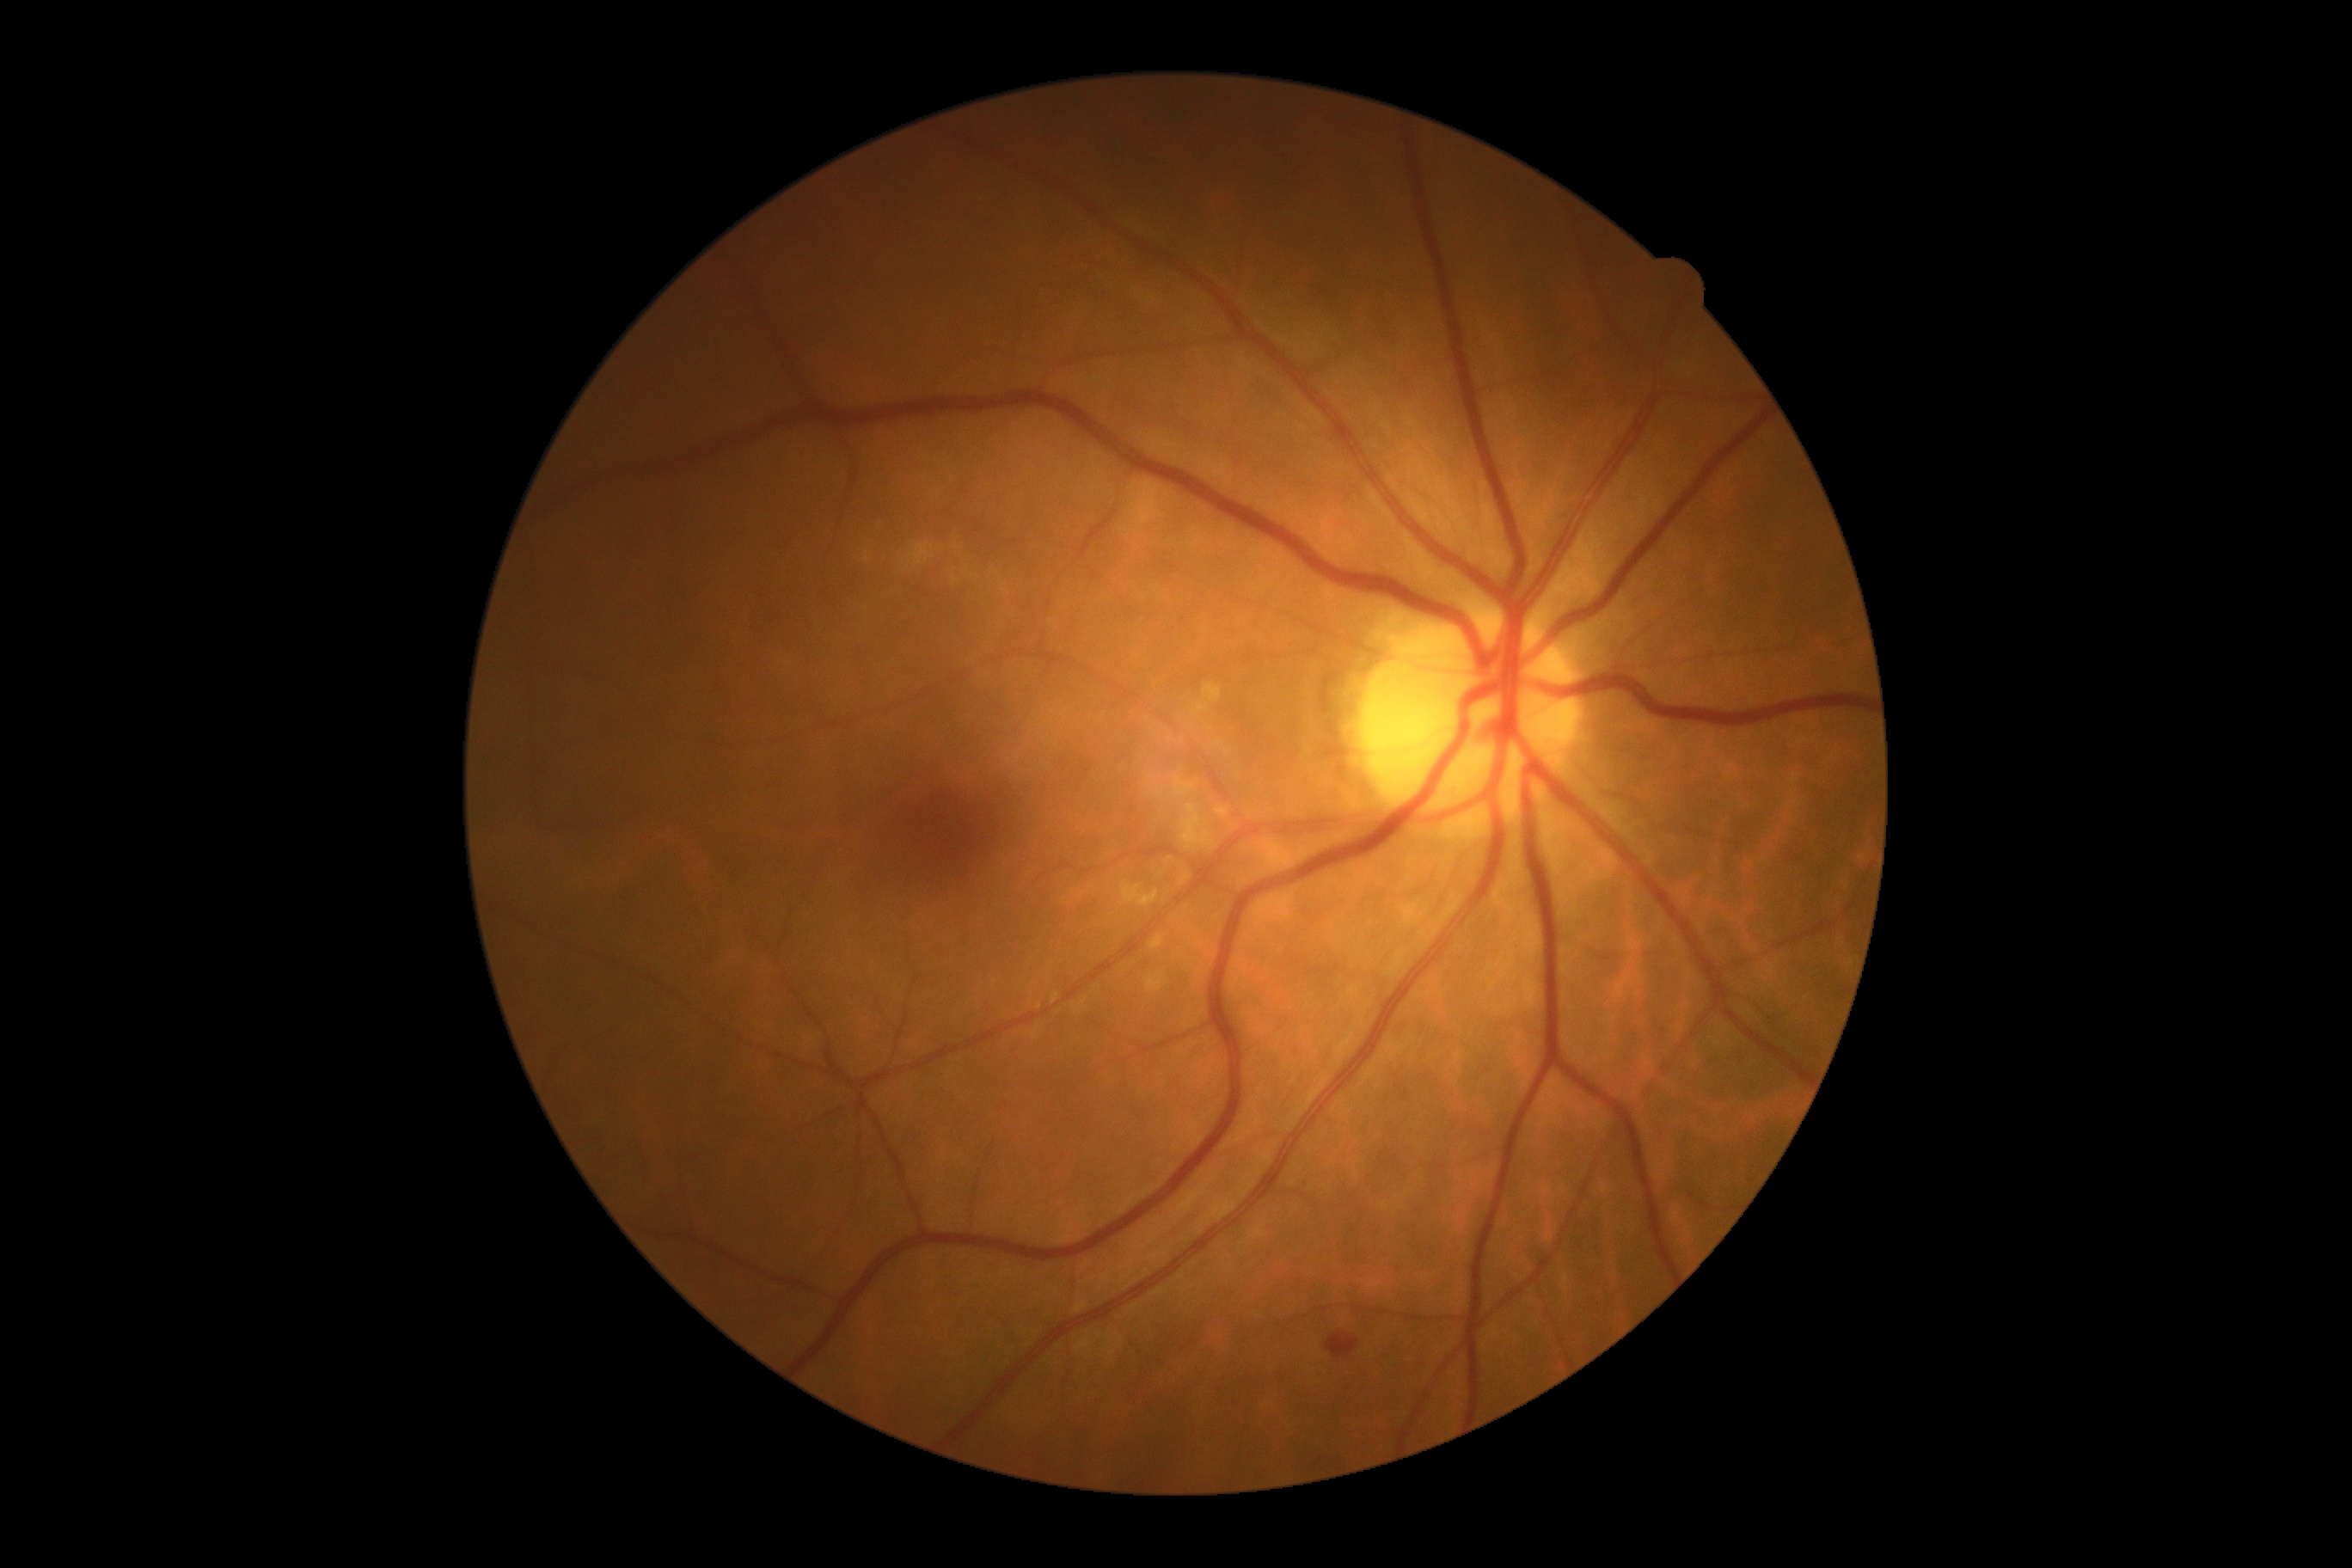

DR class: non-proliferative diabetic retinopathy.
DR stage: moderate NPDR (grade 2).